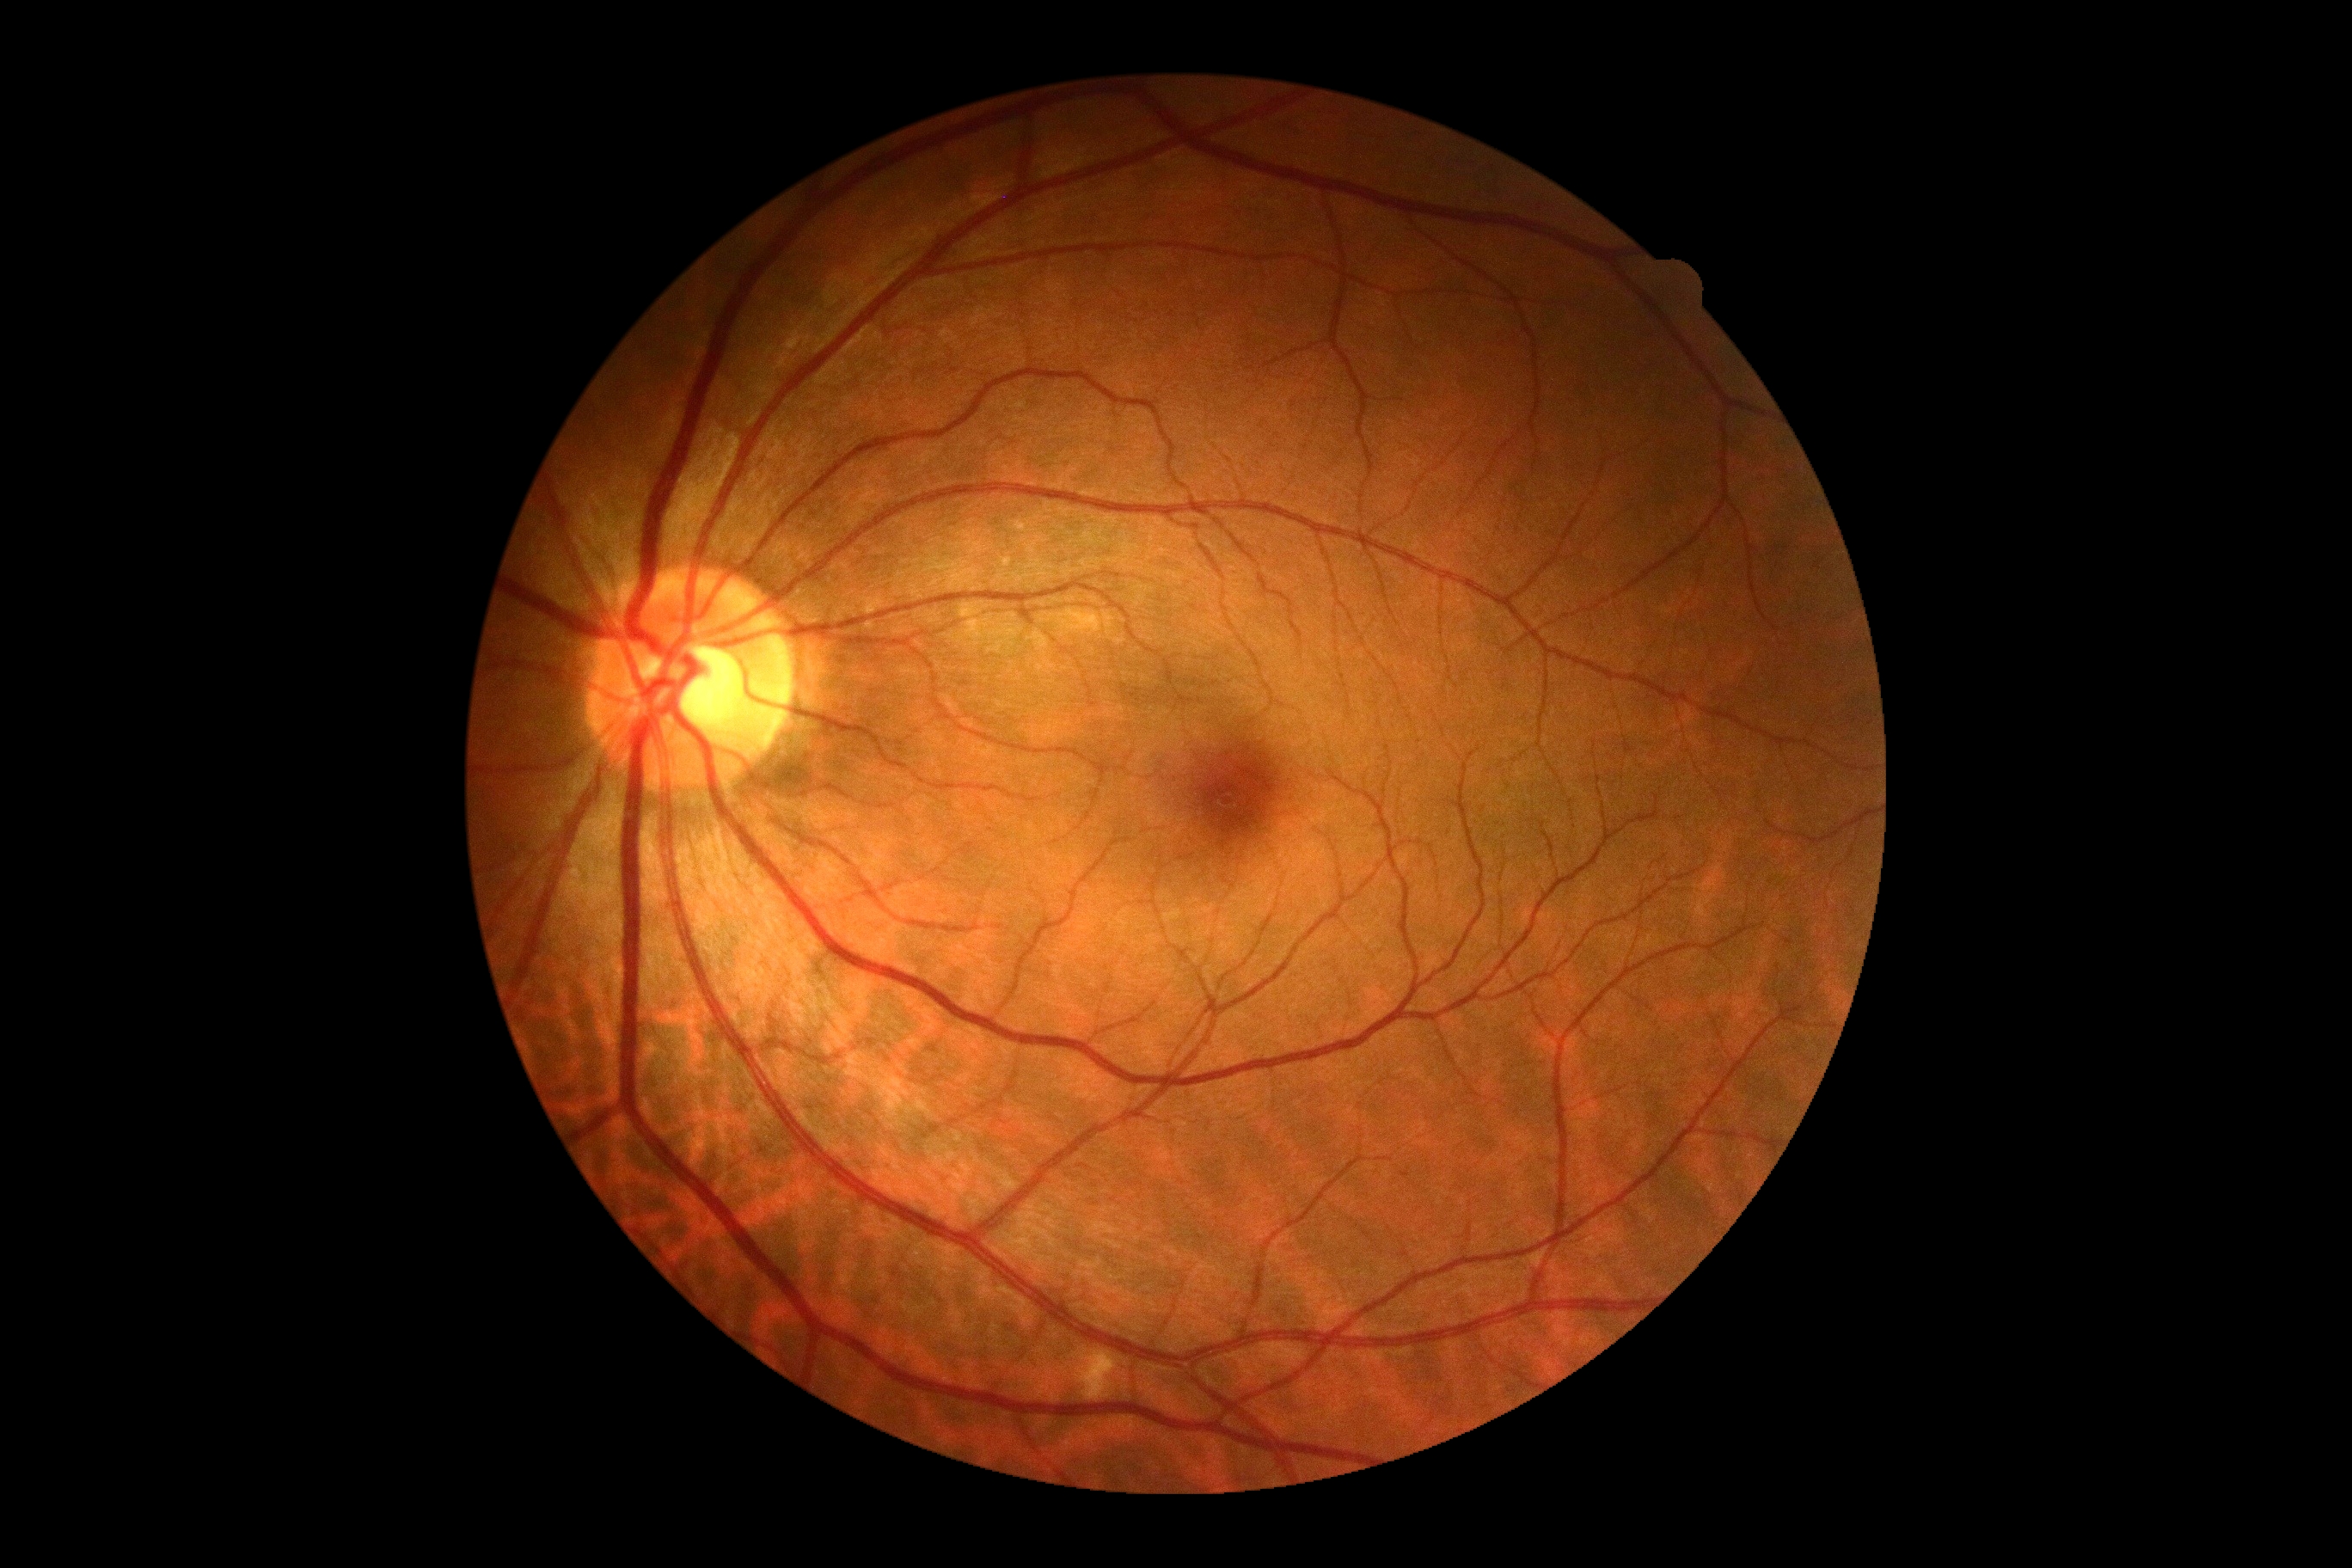 Annotations:
• retinopathy grade — 0/4
• DR impression — no signs of DR